CFP.
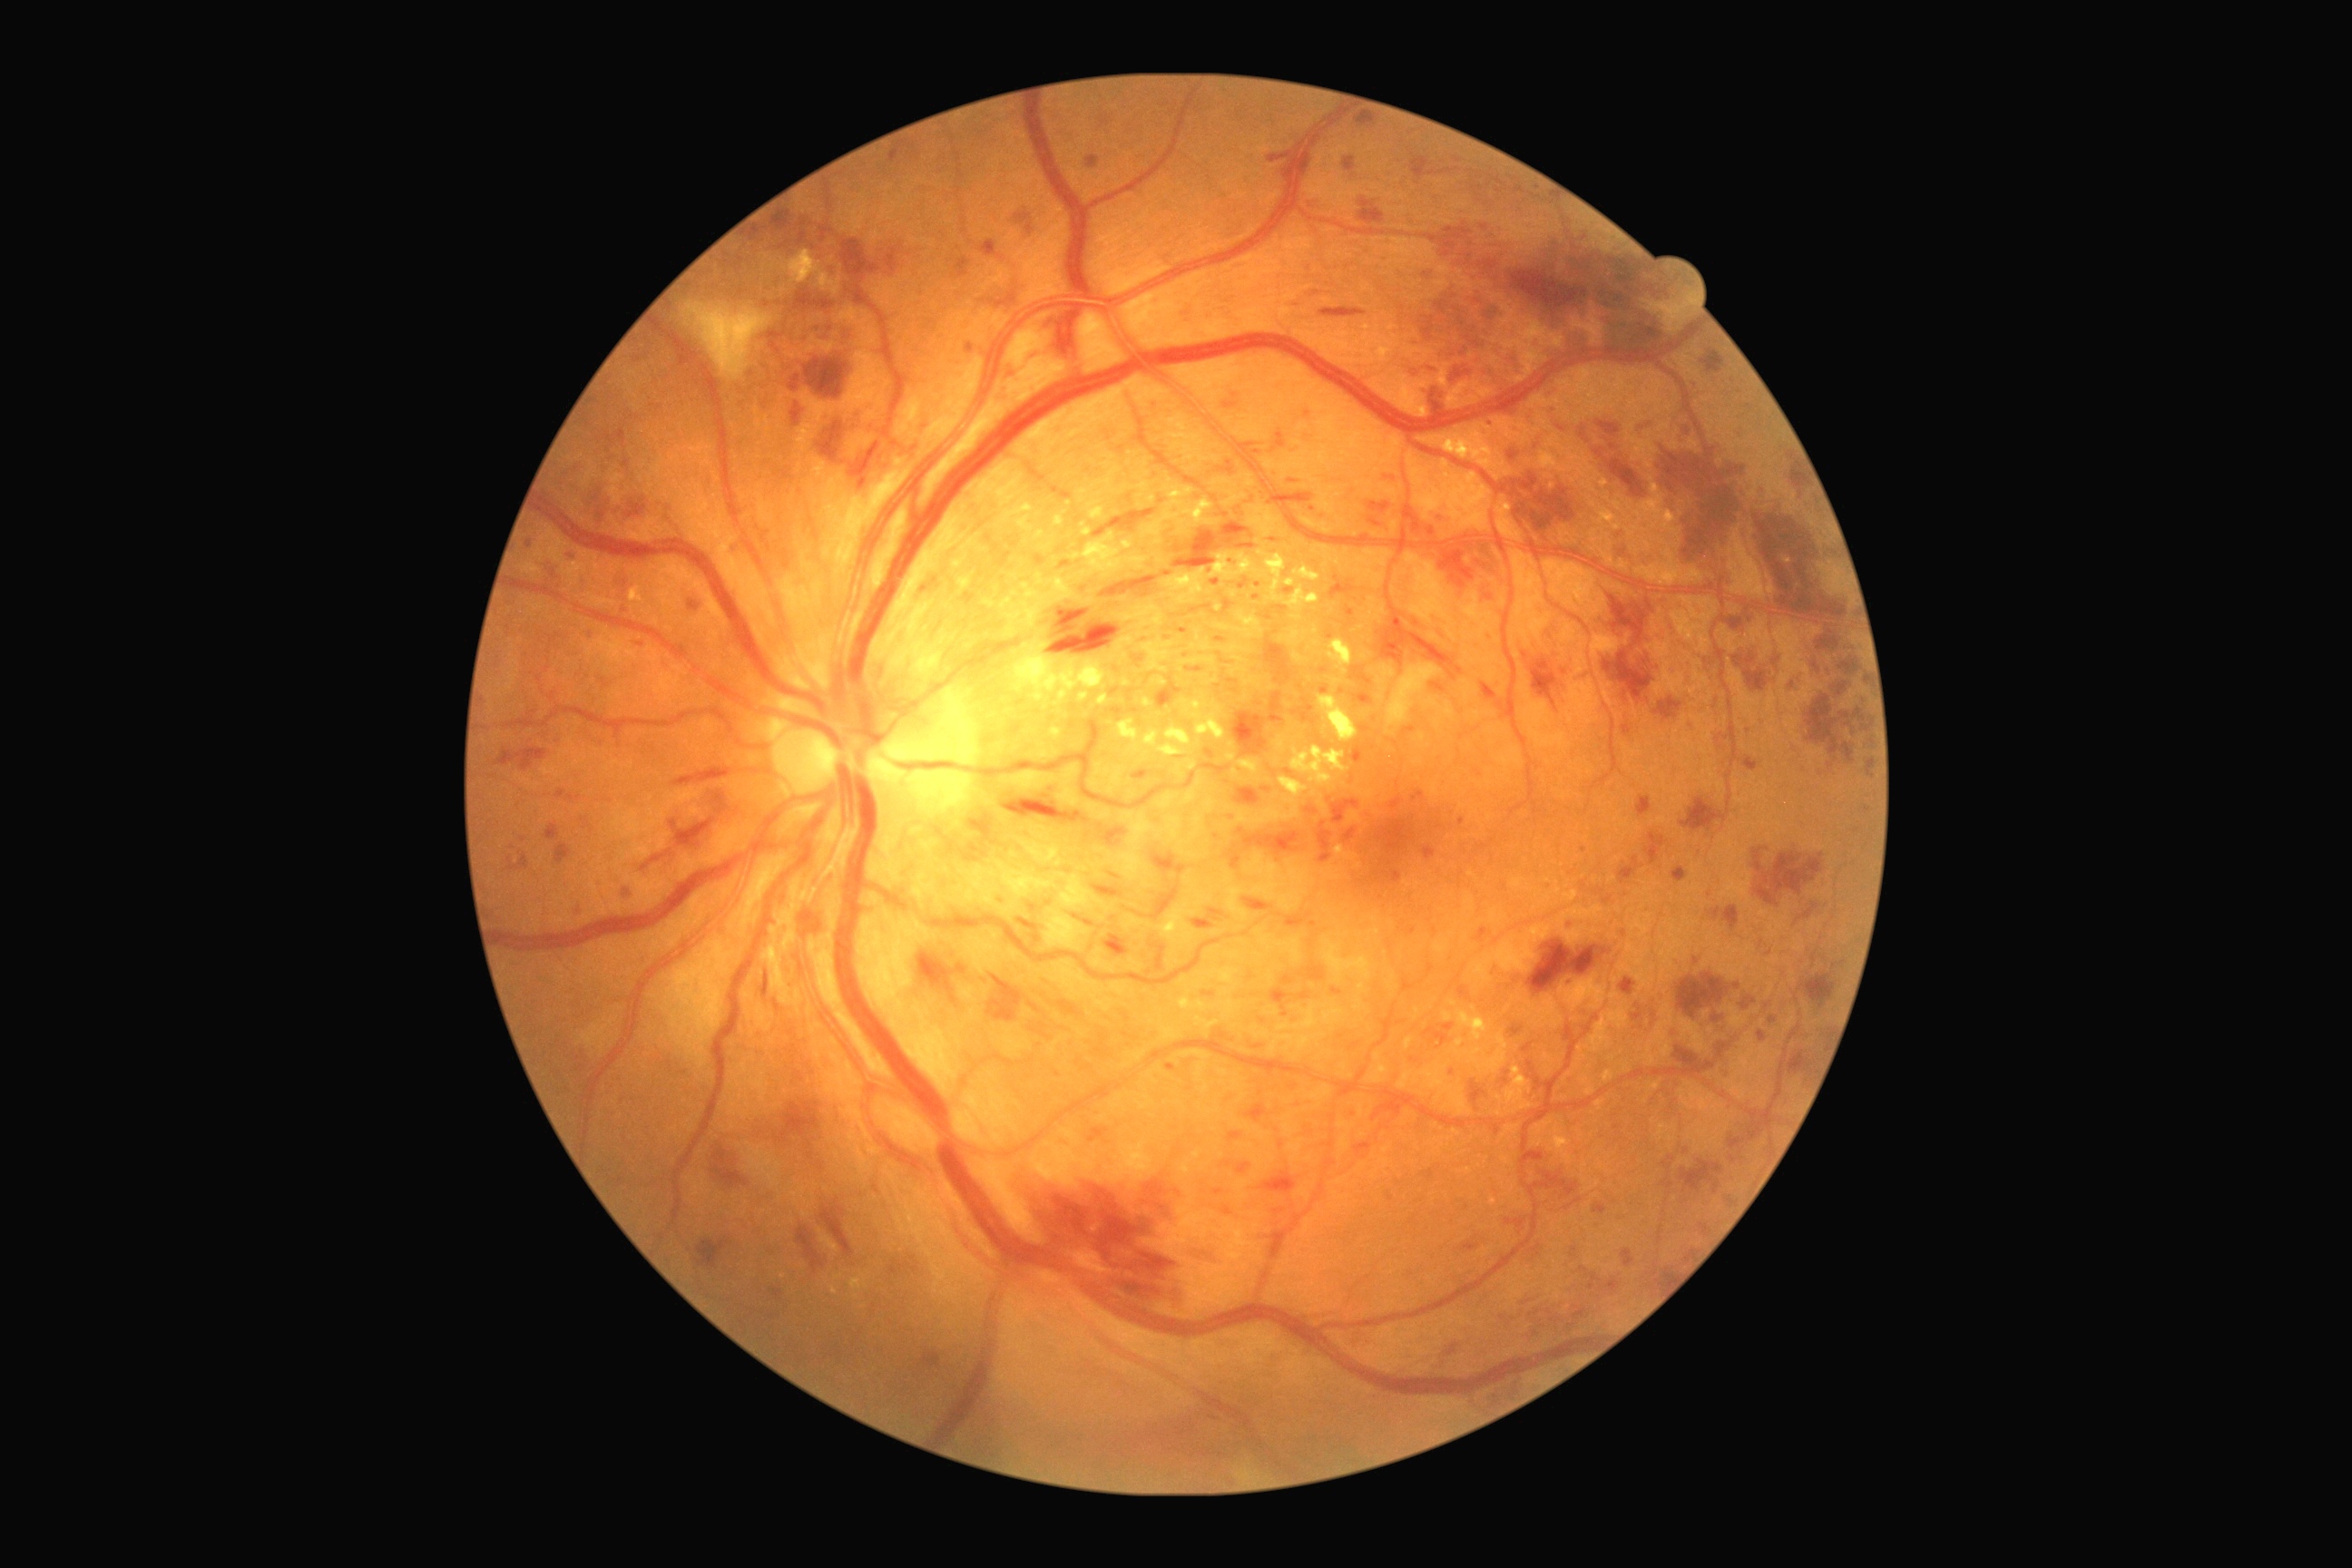
DR stage is grade 3 — more than 20 intraretinal hemorrhages in each of 4 quadrants, definite venous beading in 2 or more quadrants, or prominent intraretinal microvascular abnormalities in 1 or more quadrants, with no signs of proliferative retinopathy
Representative lesions:
MAs (partial): <region>1758, 1032, 1767, 1044</region> | <region>1349, 1110, 1358, 1119</region> | <region>1300, 992, 1309, 999</region> | <region>1716, 1043, 1730, 1059</region> | <region>1444, 1023, 1455, 1032</region> | <region>1266, 614, 1271, 622</region> | <region>956, 259, 970, 279</region> | <region>1253, 1044, 1264, 1050</region> | <region>1527, 1152, 1545, 1162</region> | <region>816, 328, 838, 346</region> | <region>1222, 1161, 1231, 1166</region> | <region>1709, 908, 1721, 921</region> | <region>1458, 986, 1469, 999</region> | <region>1331, 988, 1342, 995</region>
Small MAs approximately at x=641 y=645 | x=1286 y=1014 | x=1329 y=800 | x=1737 y=987 | x=1306 y=701